Davis DR grading — 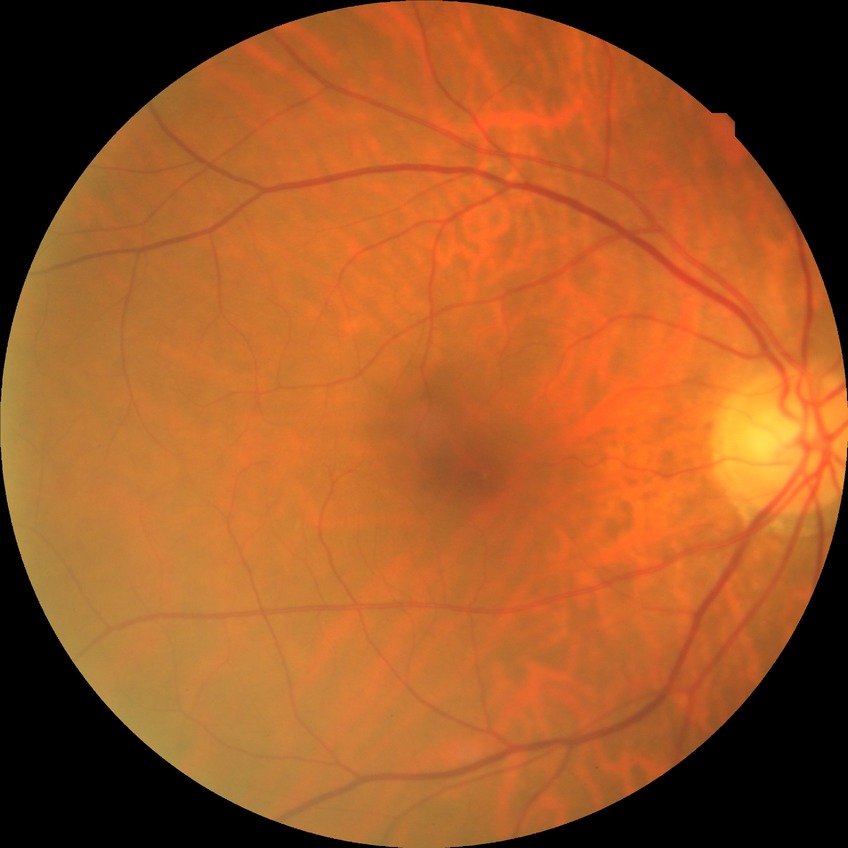
Diabetic retinopathy (DR): NDR (no diabetic retinopathy).